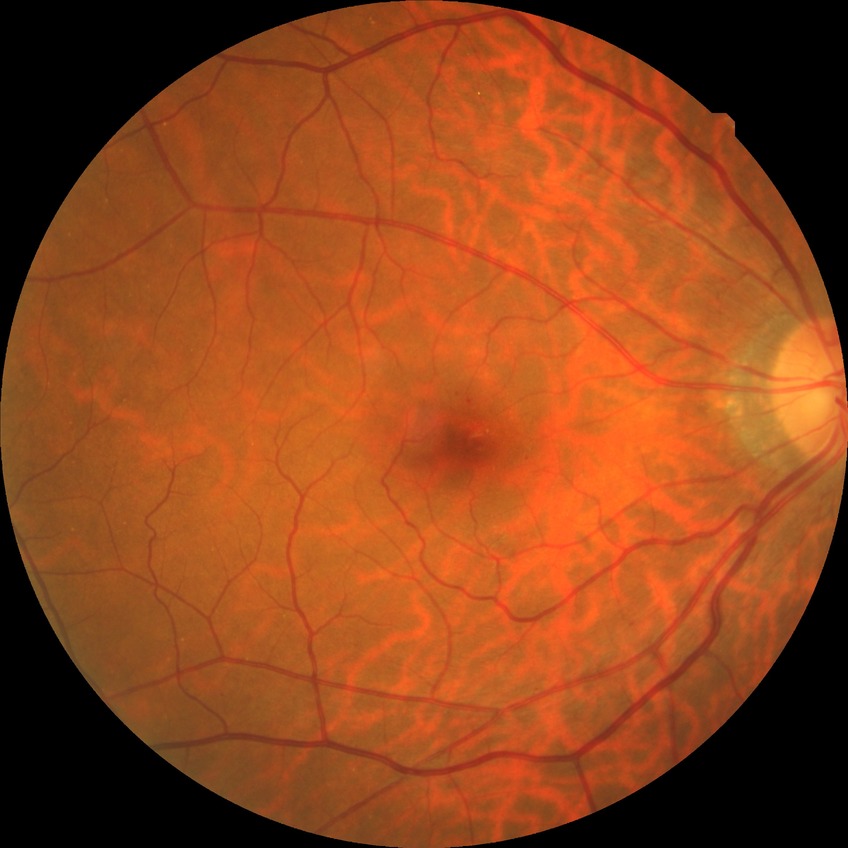
Diabetic retinopathy (DR): SDR (simple diabetic retinopathy). The retinopathy is classified as non-proliferative diabetic retinopathy.